Fundus photo.
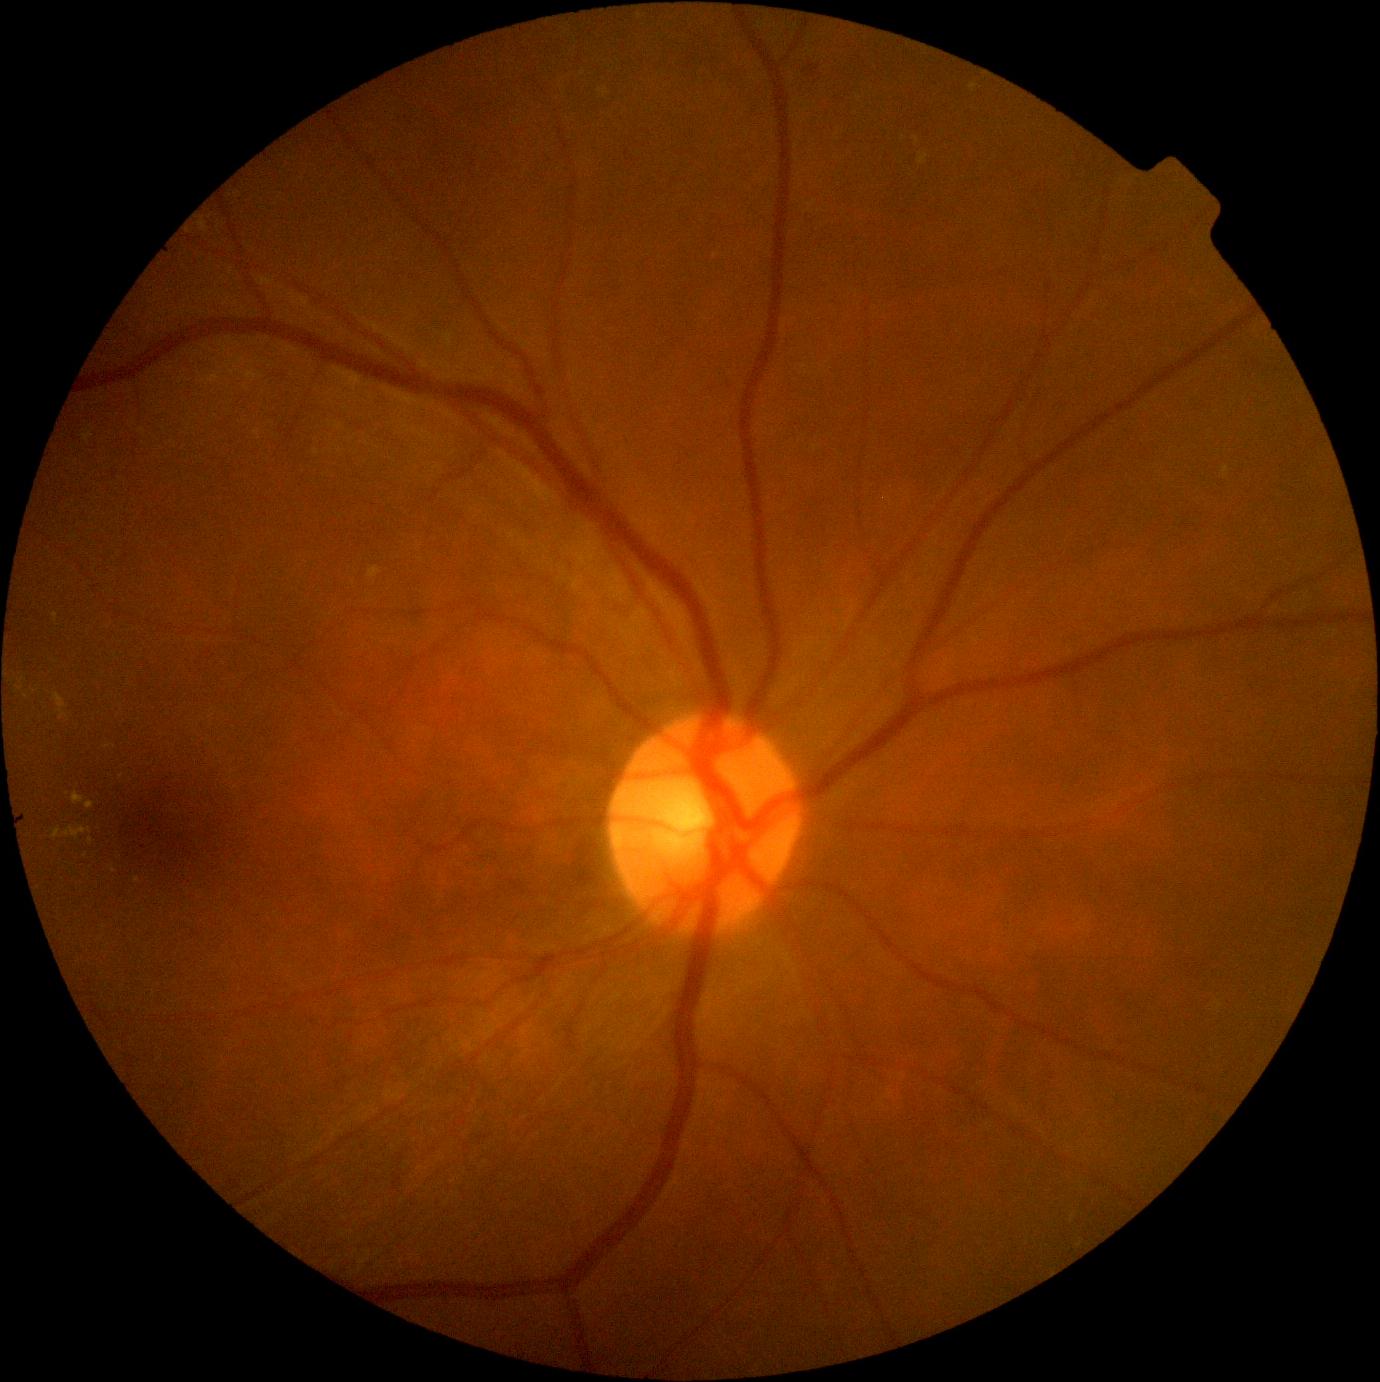

Annotations:
* diabetic retinopathy grade: 2 — more than just microaneurysms but less than severe NPDR